CFP; FOV: 45 degrees:
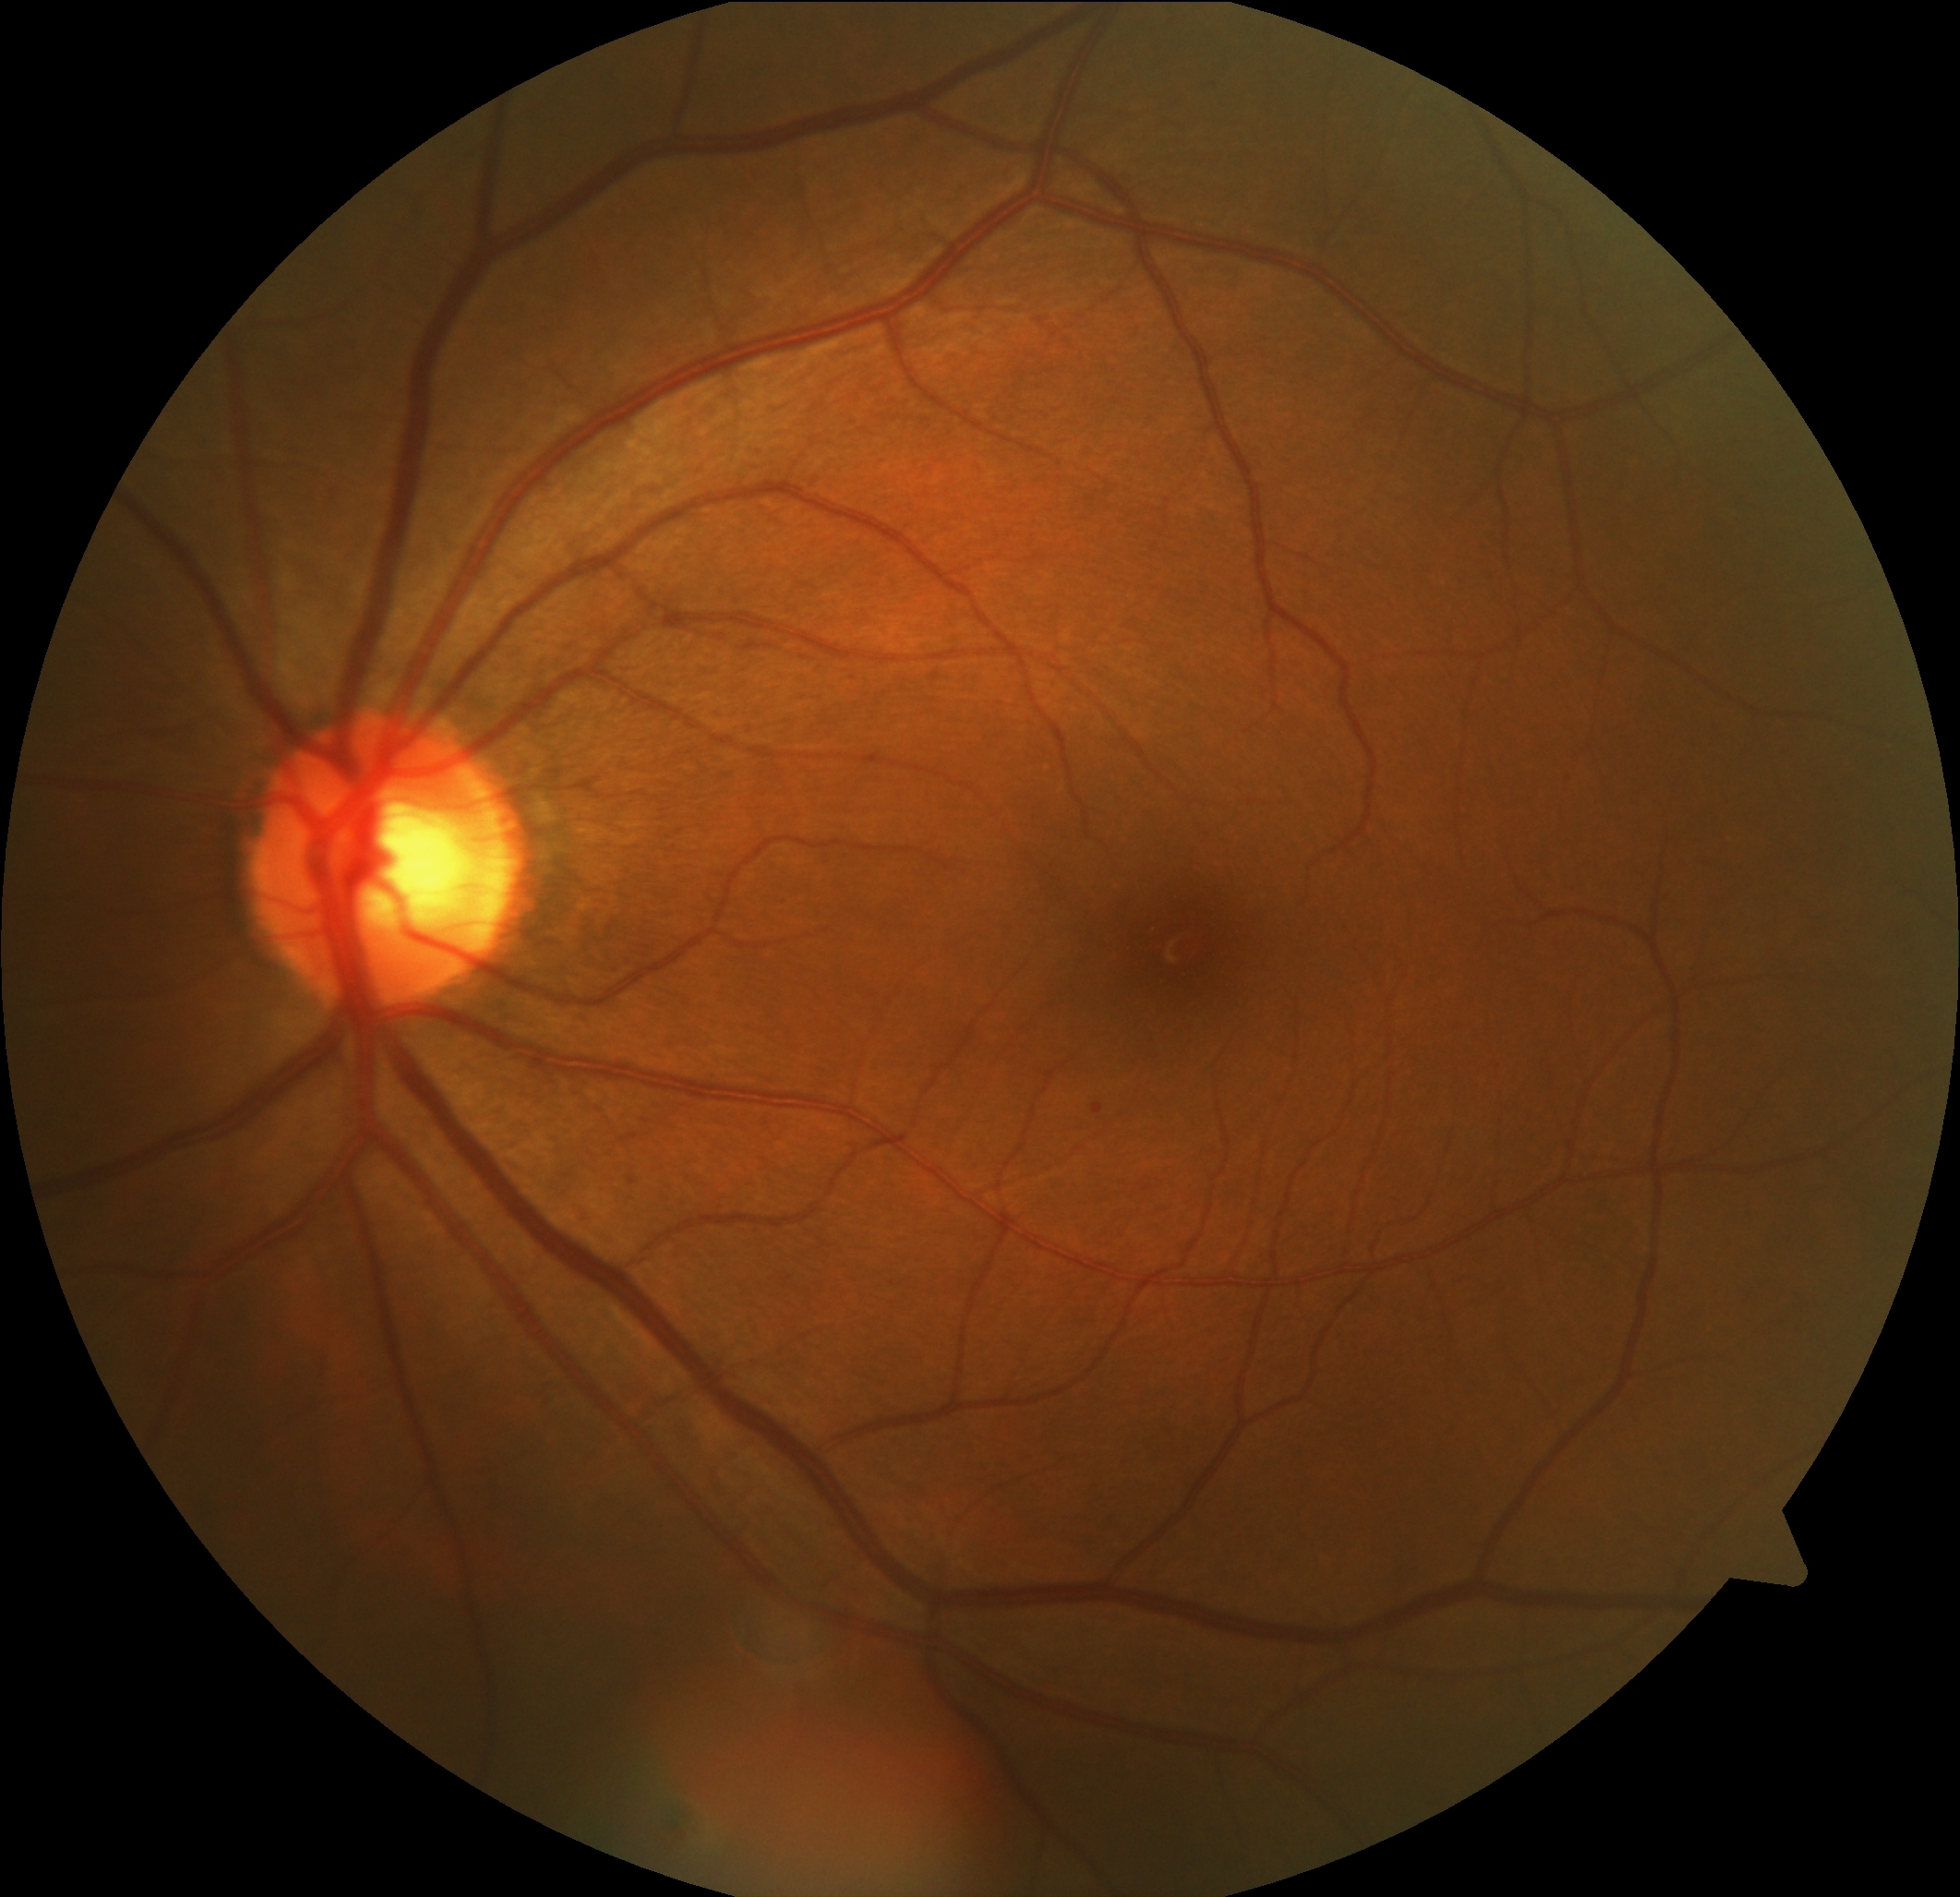 Diabetic retinopathy is mild non-proliferative diabetic retinopathy (grade 1)
soft exudates: none identified
hard exudates: none identified
microaneurysms: 1094,1103,1104,1115
hemorrhages: none identified